Wide-field fundus photograph from neonatal ROP screening; 130° field of view (Clarity RetCam 3); image size 640x480 — 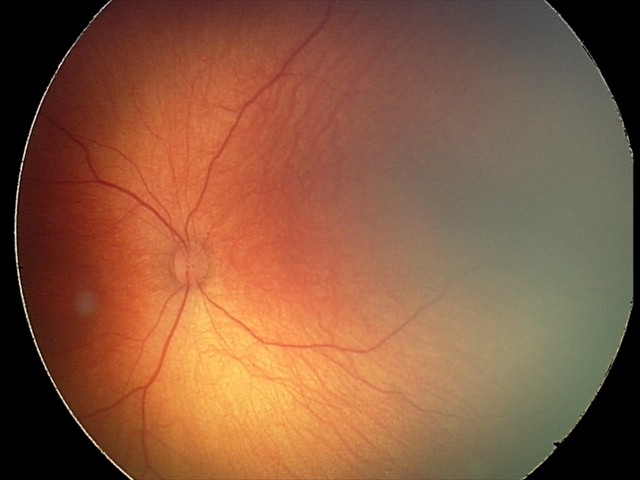
Examination with physiological retinal findings.